Retinal fundus photograph: 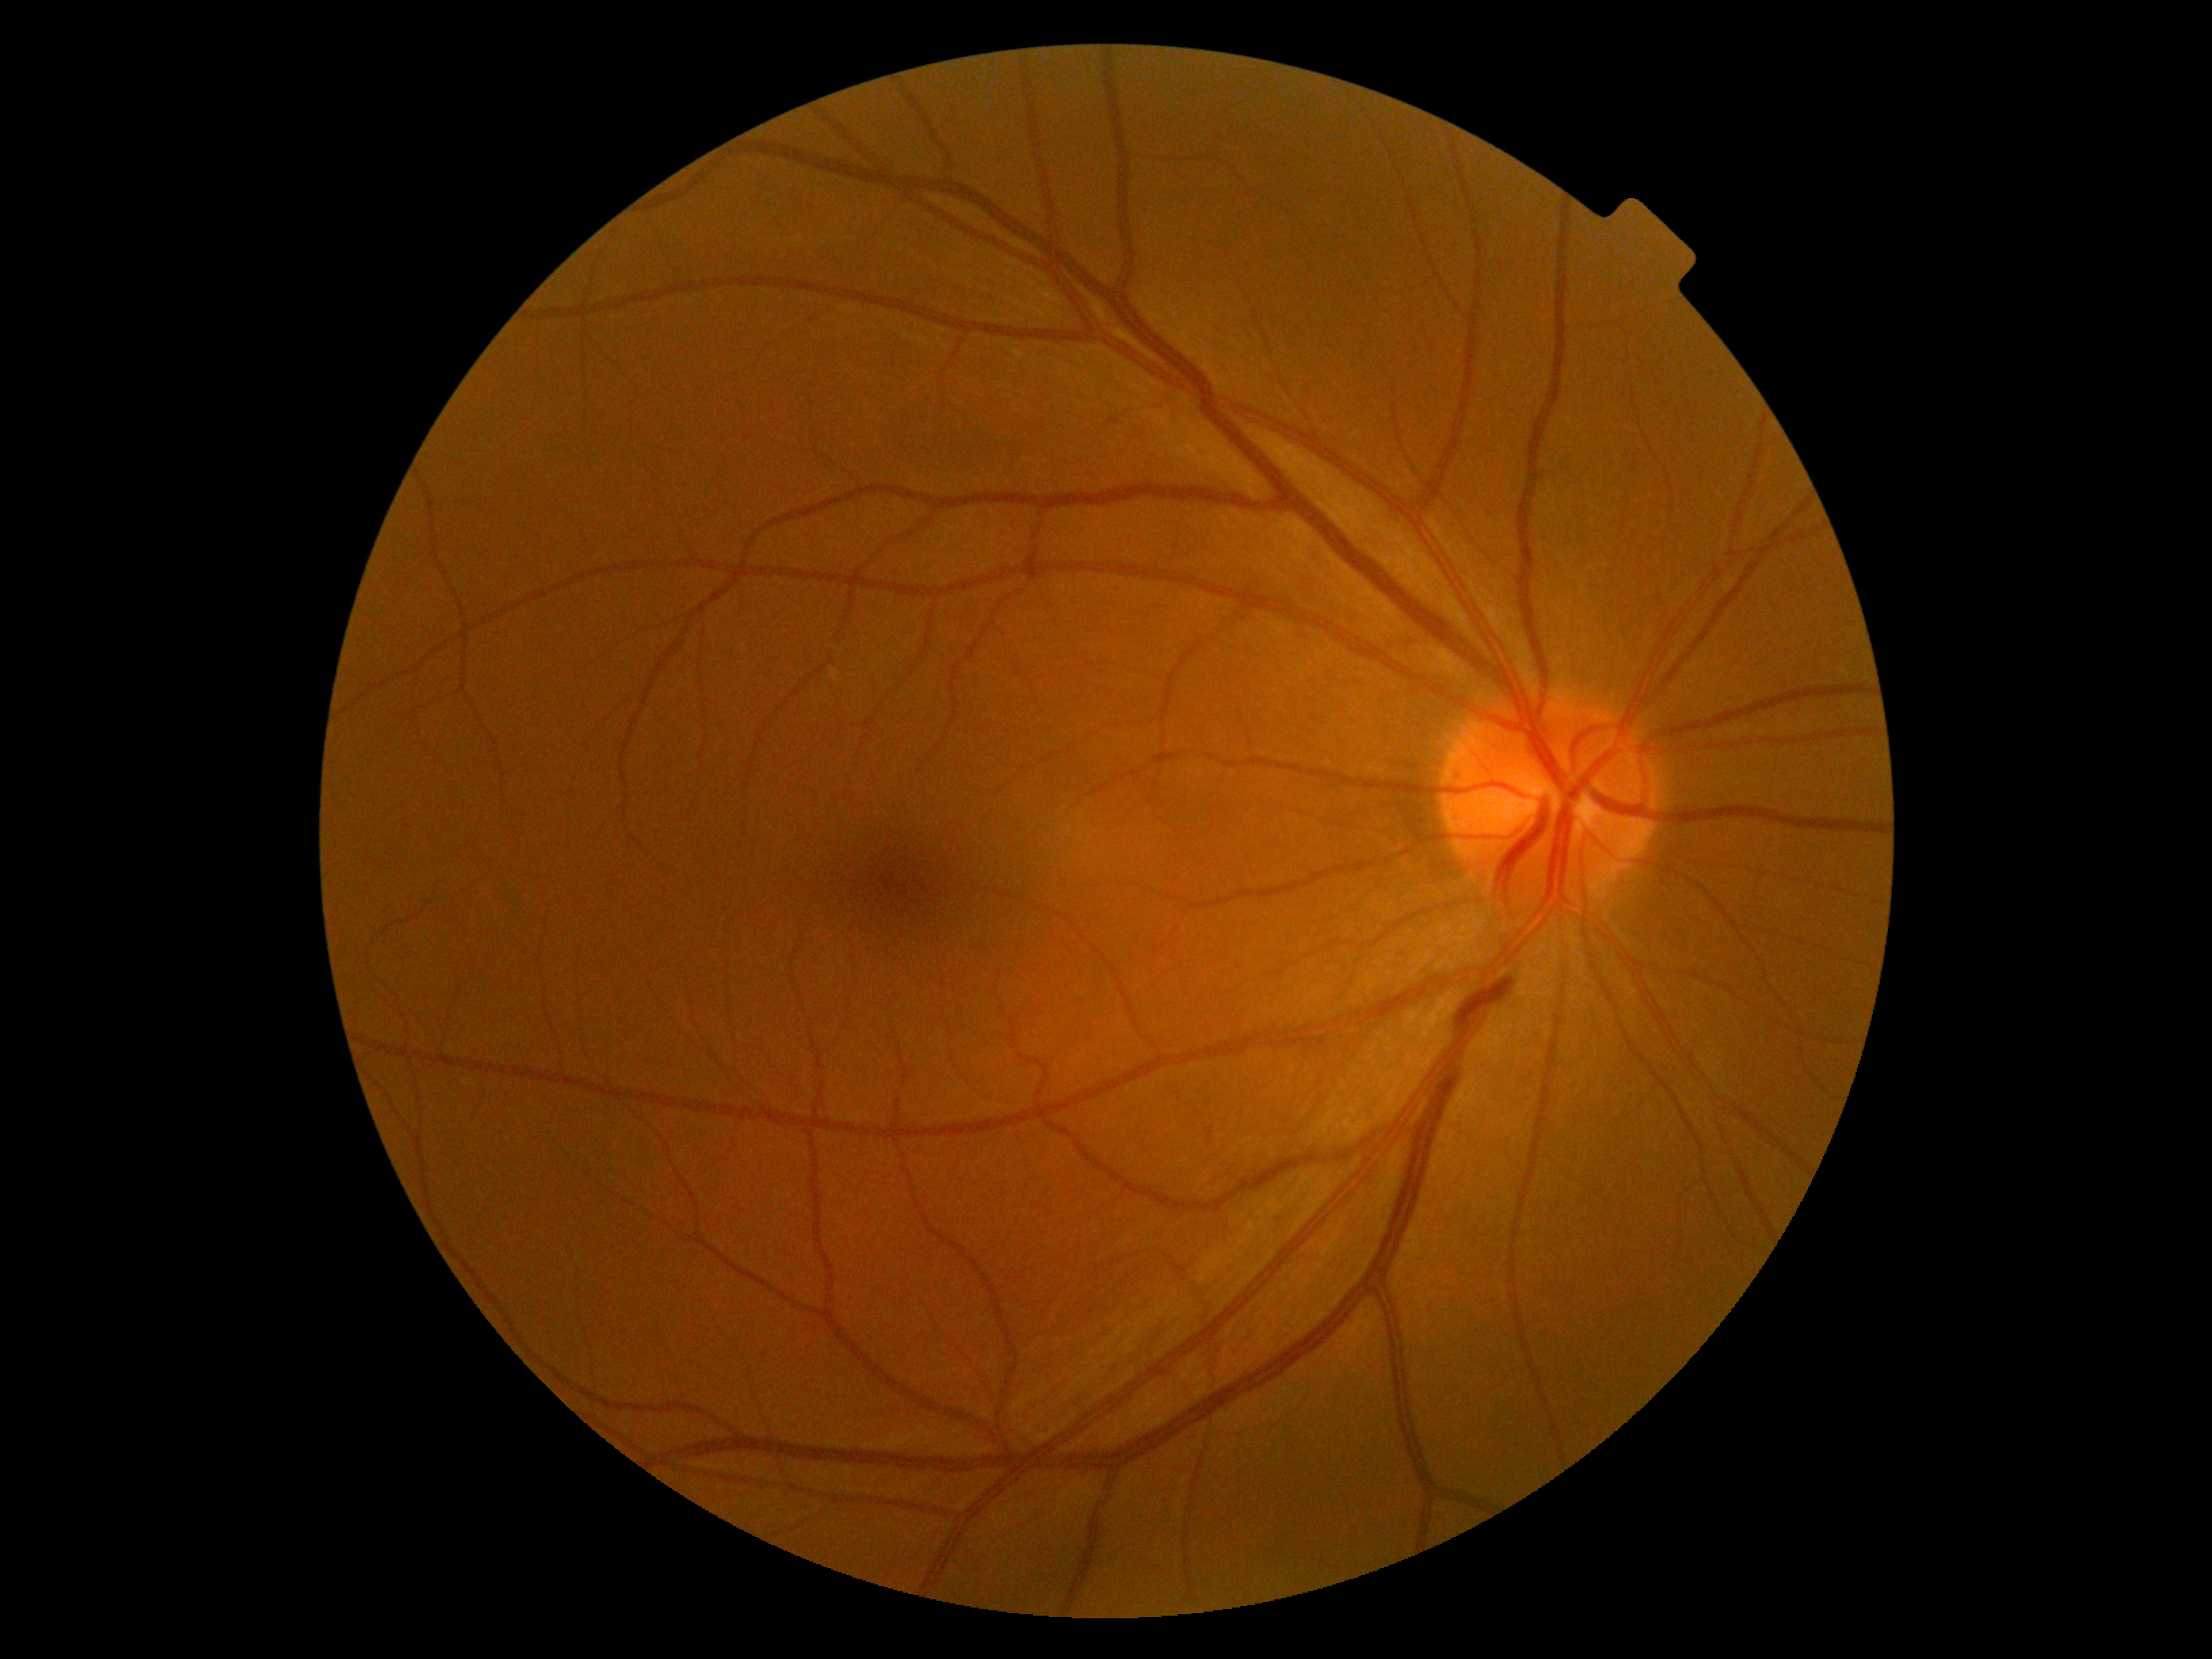 Findings:
• DR — grade 0